Clarity RetCam 3, 130° FOV. Pediatric retinal photograph (wide-field)
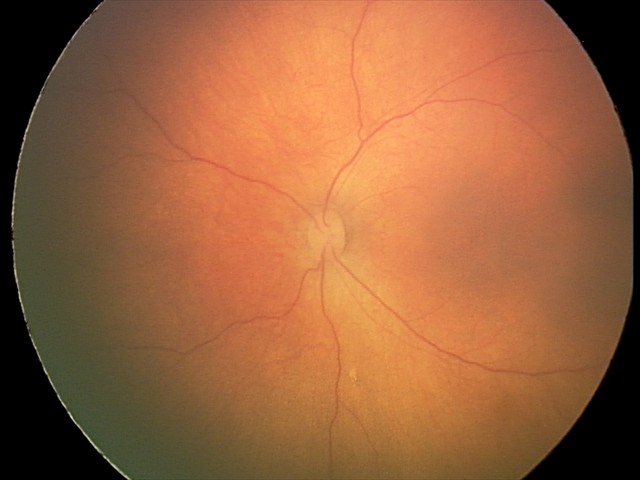

No retinal pathology identified on screening.